Retinal fundus photograph: 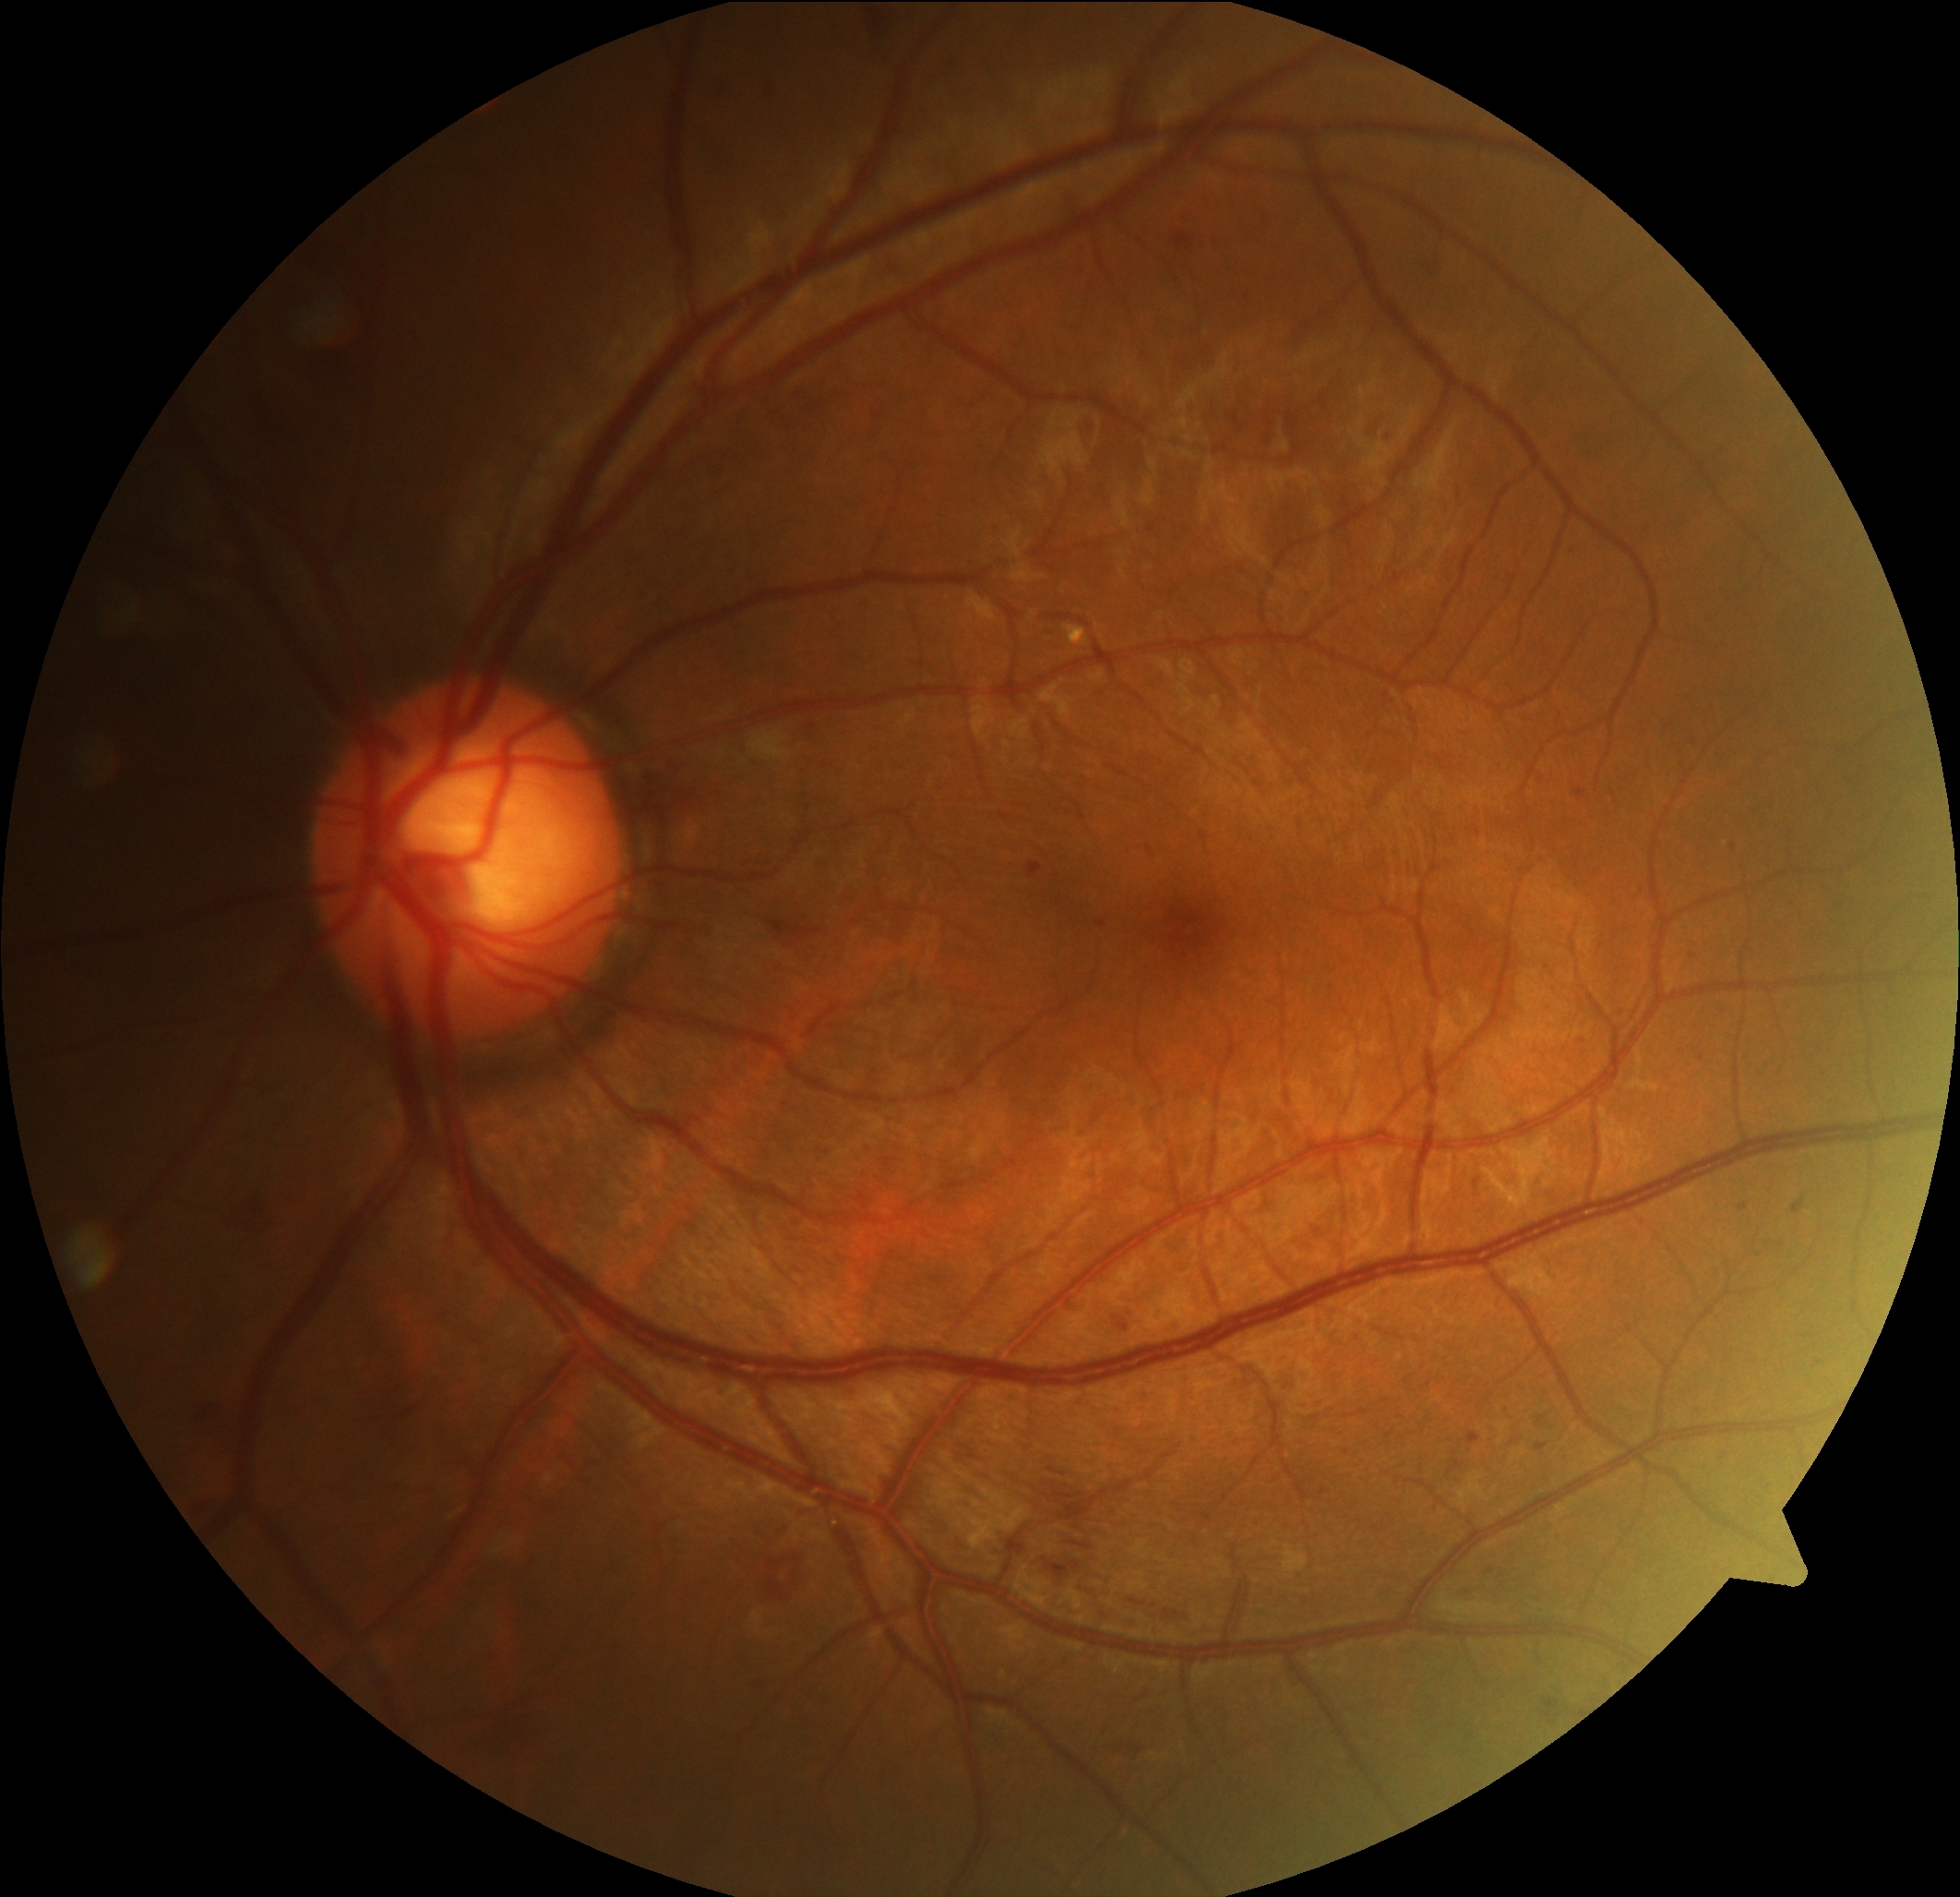 Diabetic retinopathy grade is 2 (moderate NPDR).